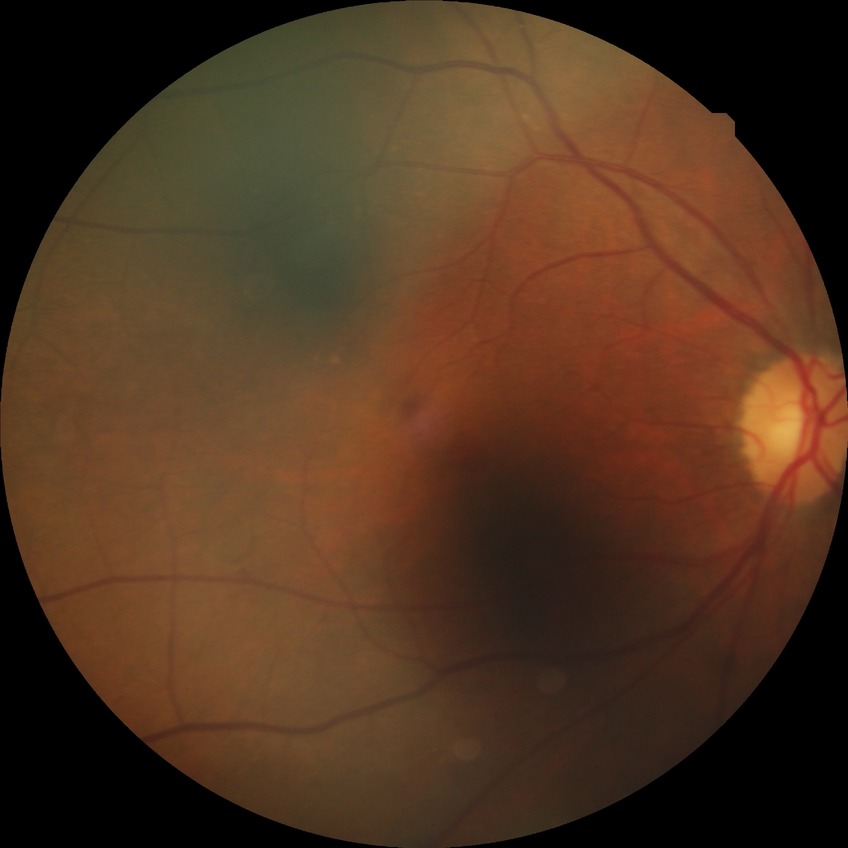 diabetic retinopathy grade = no diabetic retinopathy.